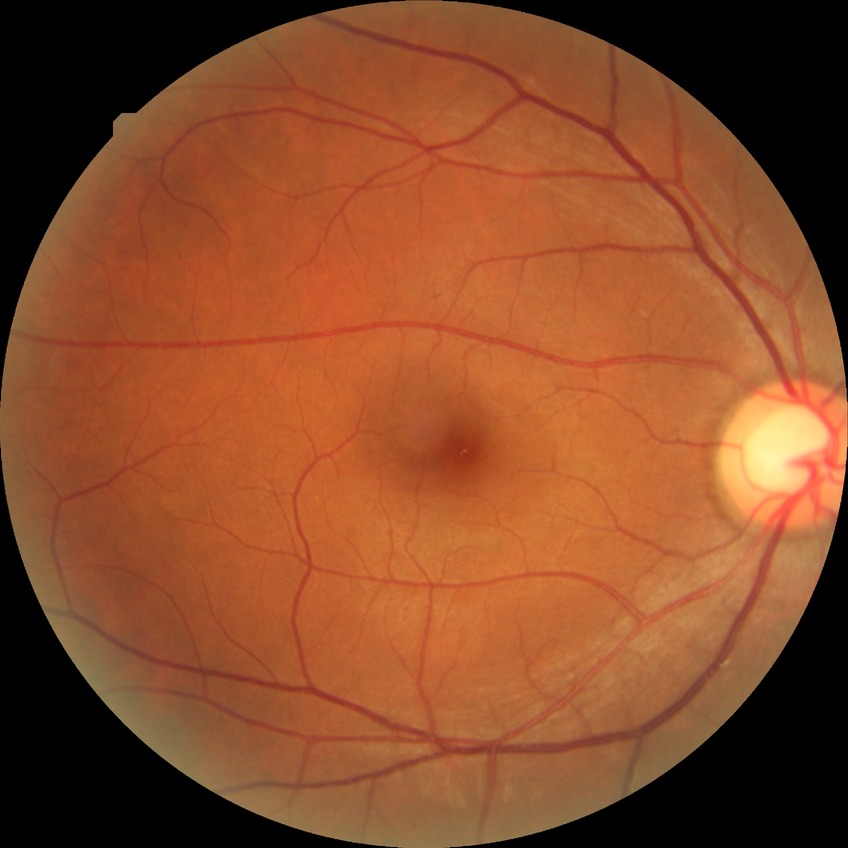

Diabetic retinopathy (DR) is NDR (no diabetic retinopathy).